Without pupil dilation. Acquired with a NIDEK AFC-230. Posterior pole photograph.
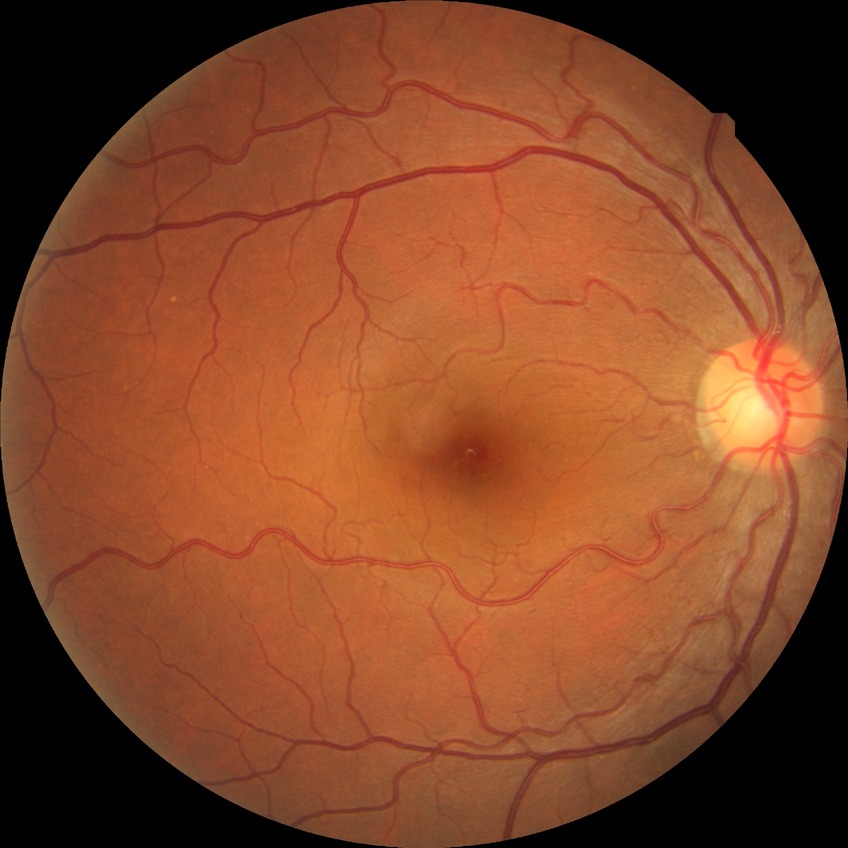 Retinopathy stage: no diabetic retinopathy.